45° FOV; CFP; 848 by 848 pixels; nonmydriatic:
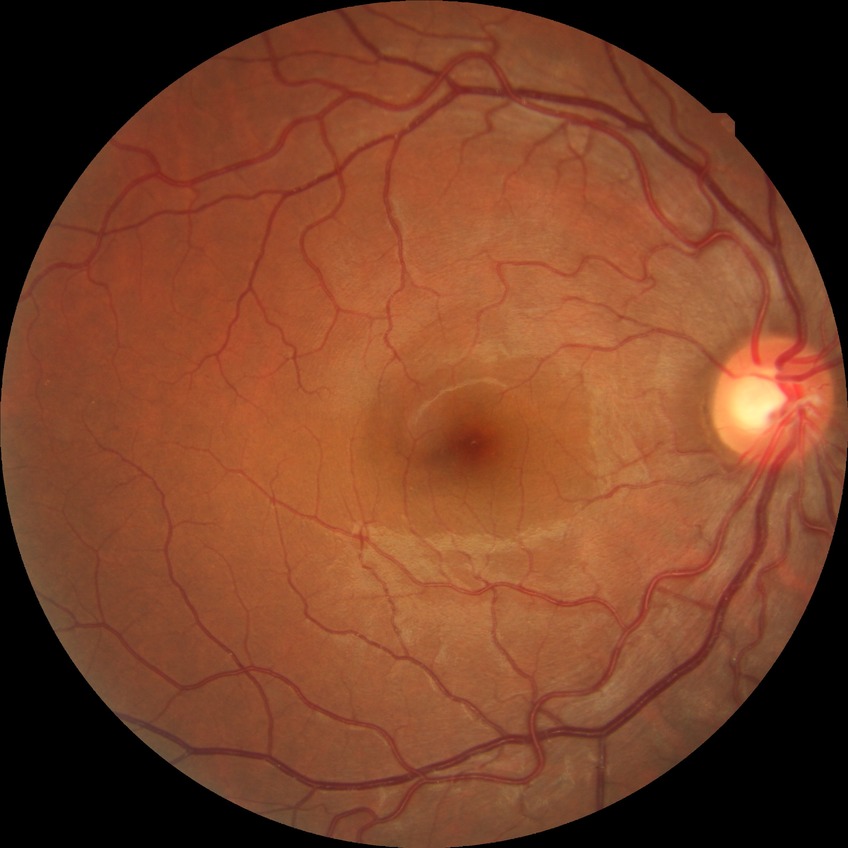

DR grade is NDR.